Nonmydriatic, 45° field of view:
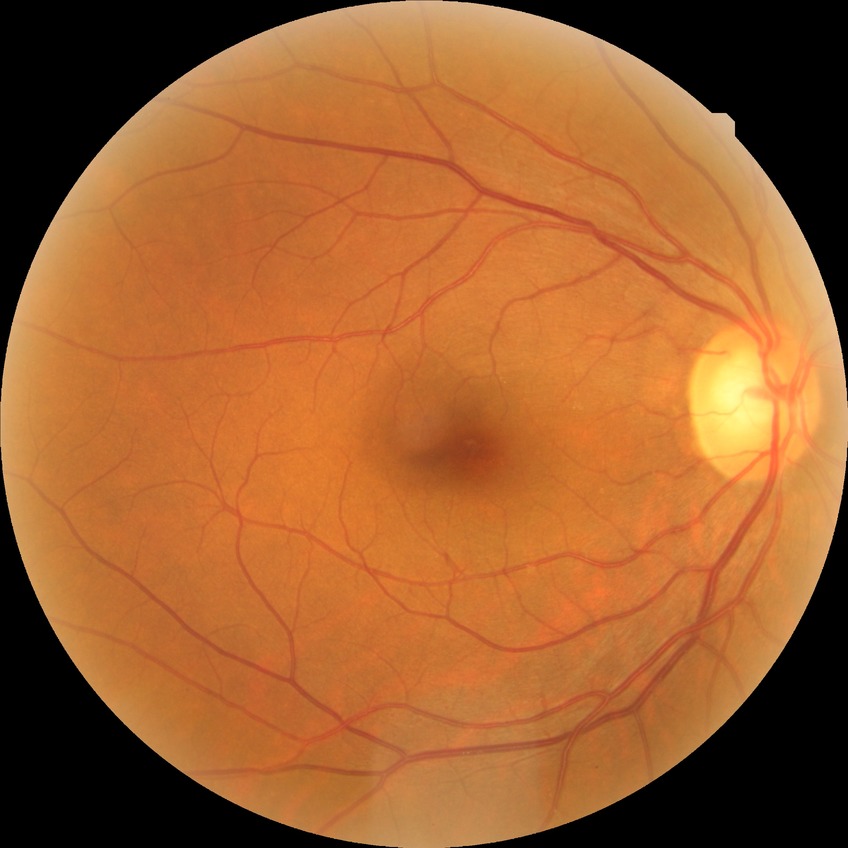 Davis grading: no diabetic retinopathy.